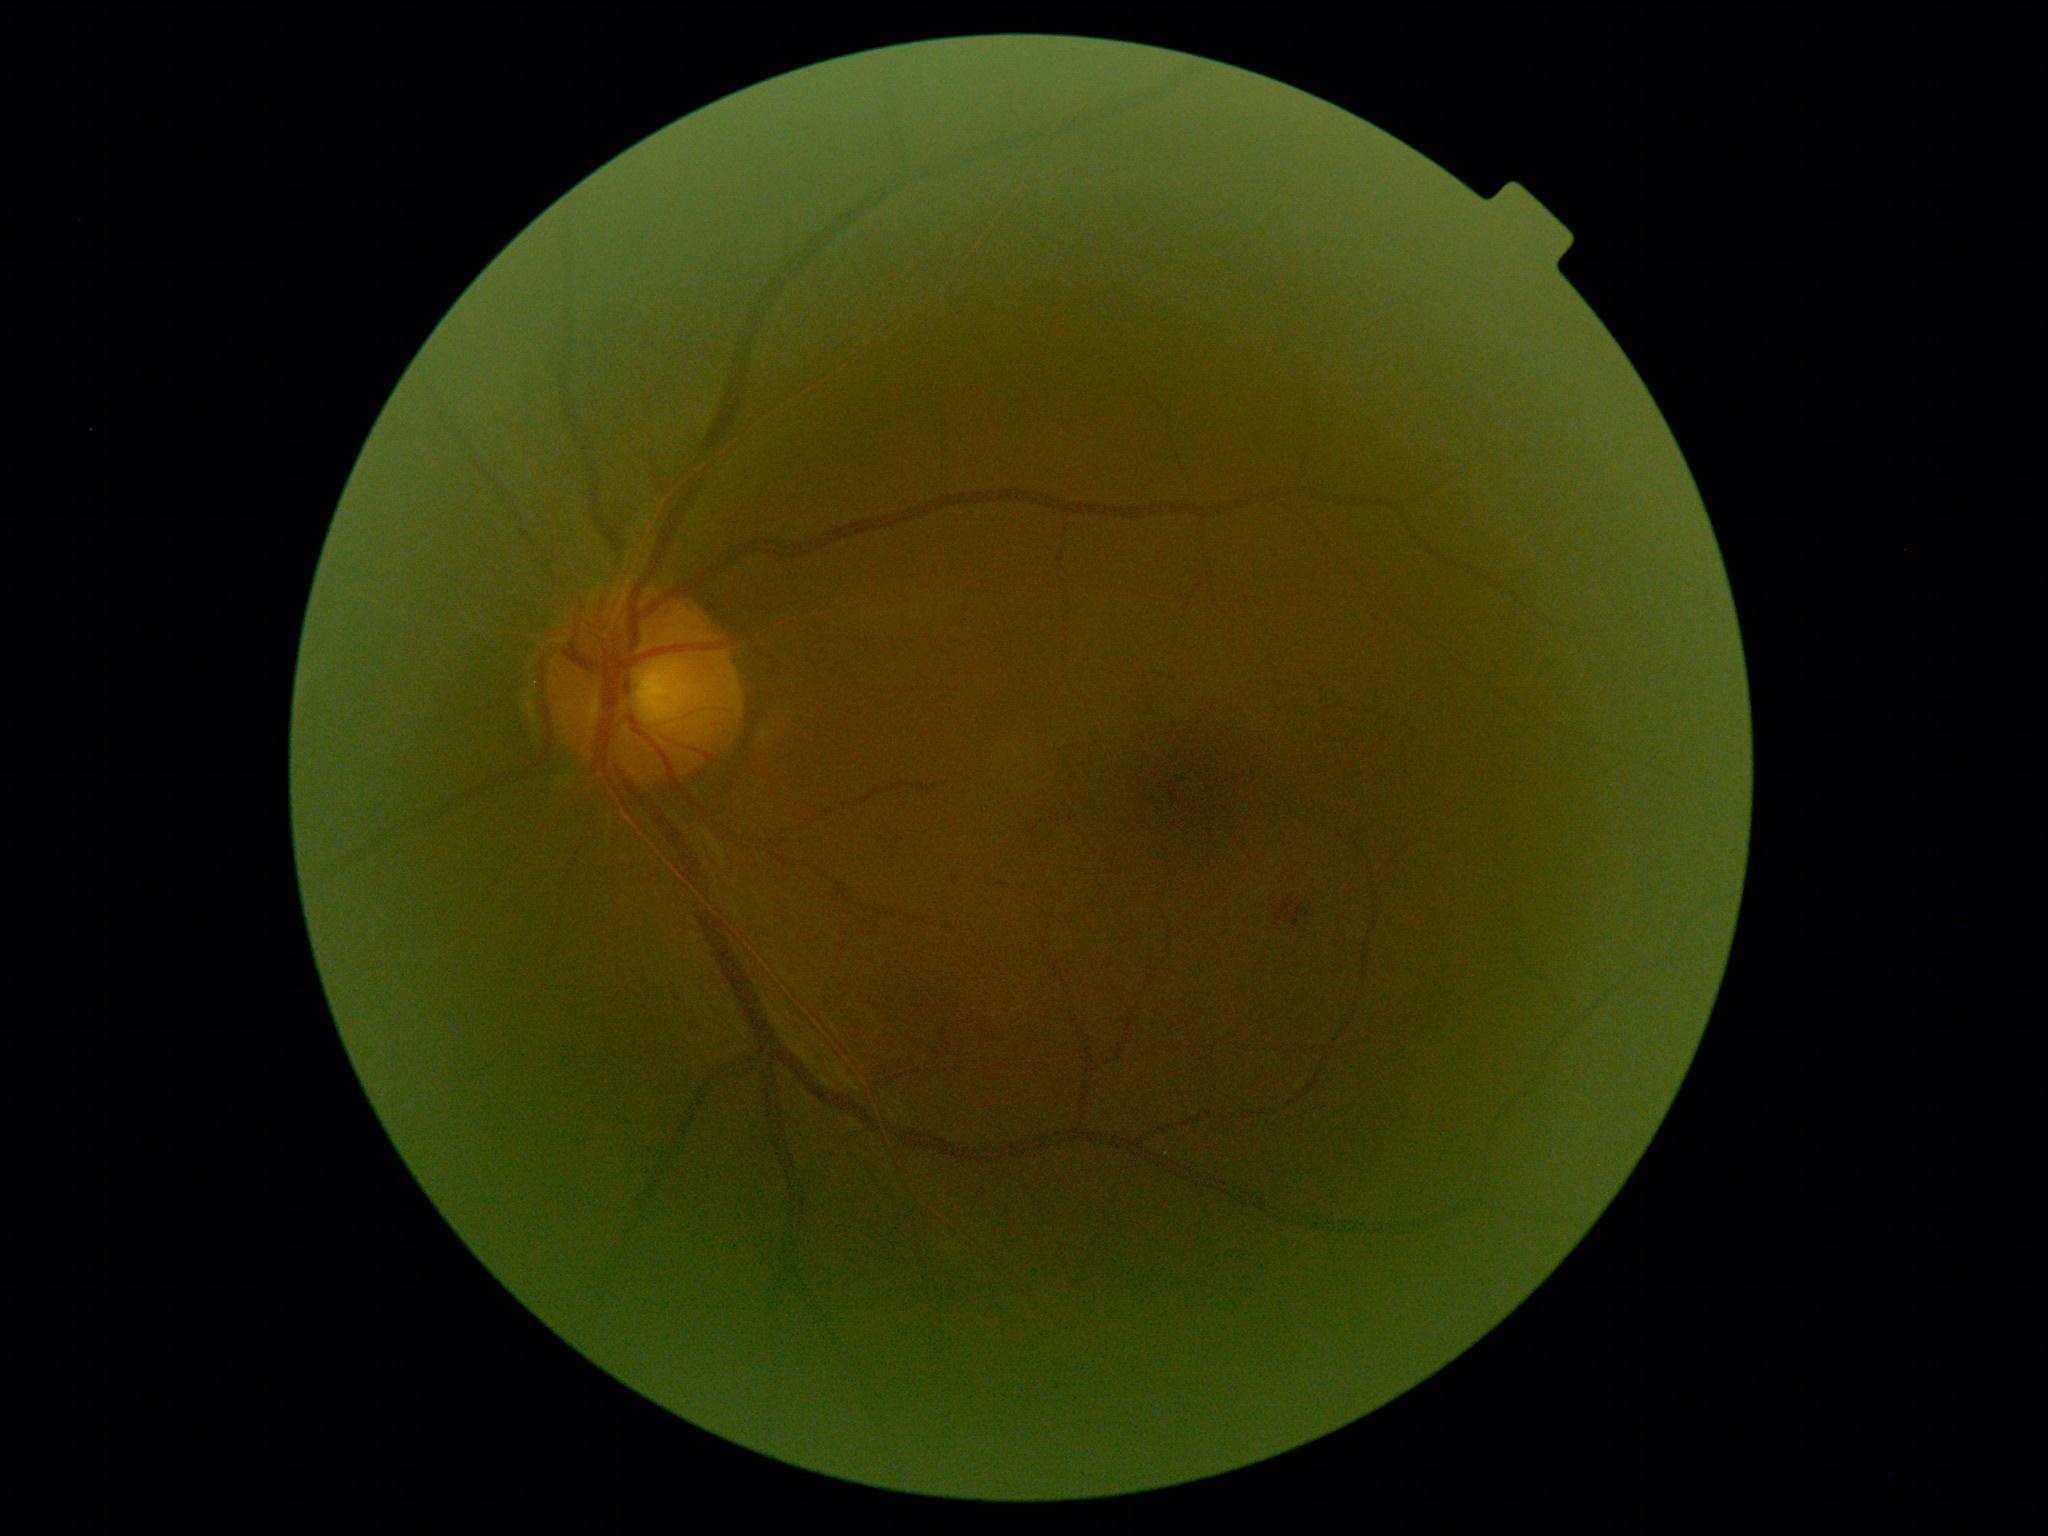
DR class: non-proliferative diabetic retinopathy. Diabetic retinopathy is grade 2 (moderate NPDR).